Without pupil dilation · Davis DR grading · color fundus image · 848x848 · 45 degree fundus photograph
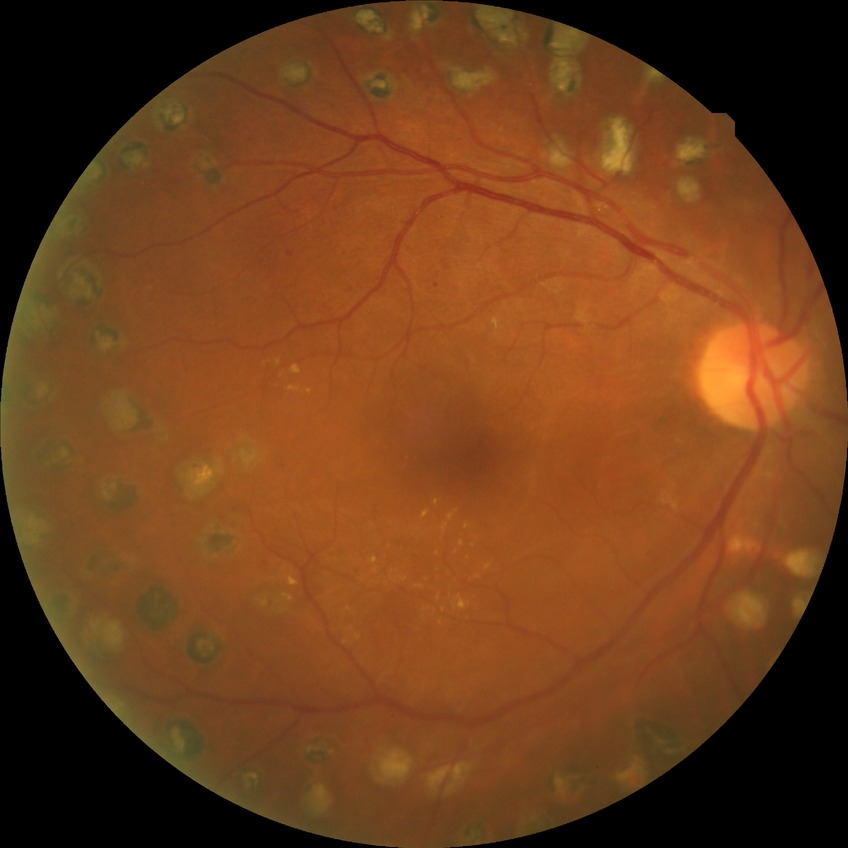 Retinopathy grade: proliferative diabetic retinopathy.